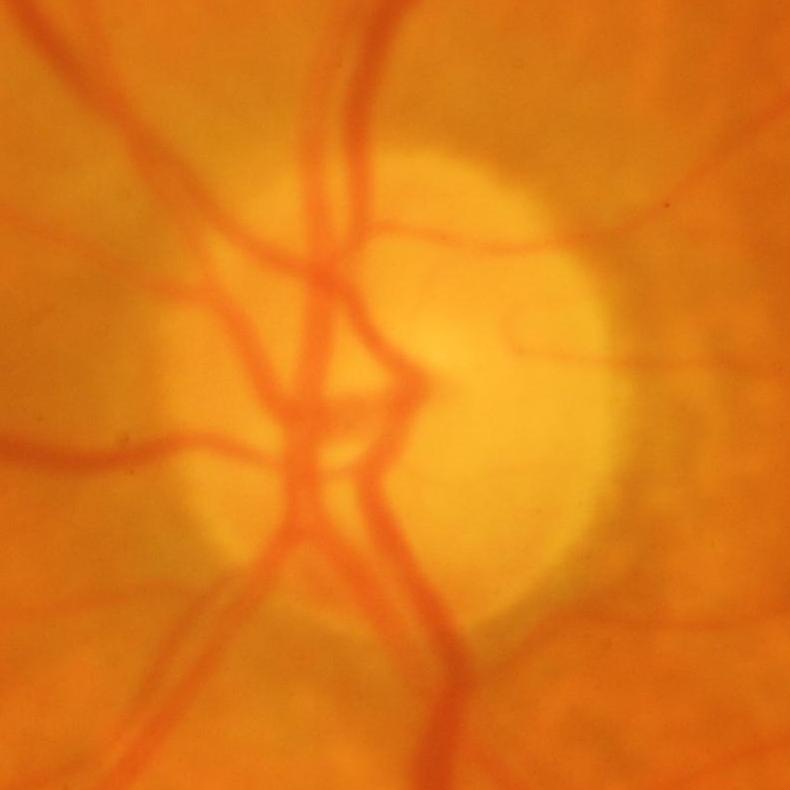
Glaucoma is present.
Glaucomatous optic neuropathy.